Pupil-dilated; 50° field of view.
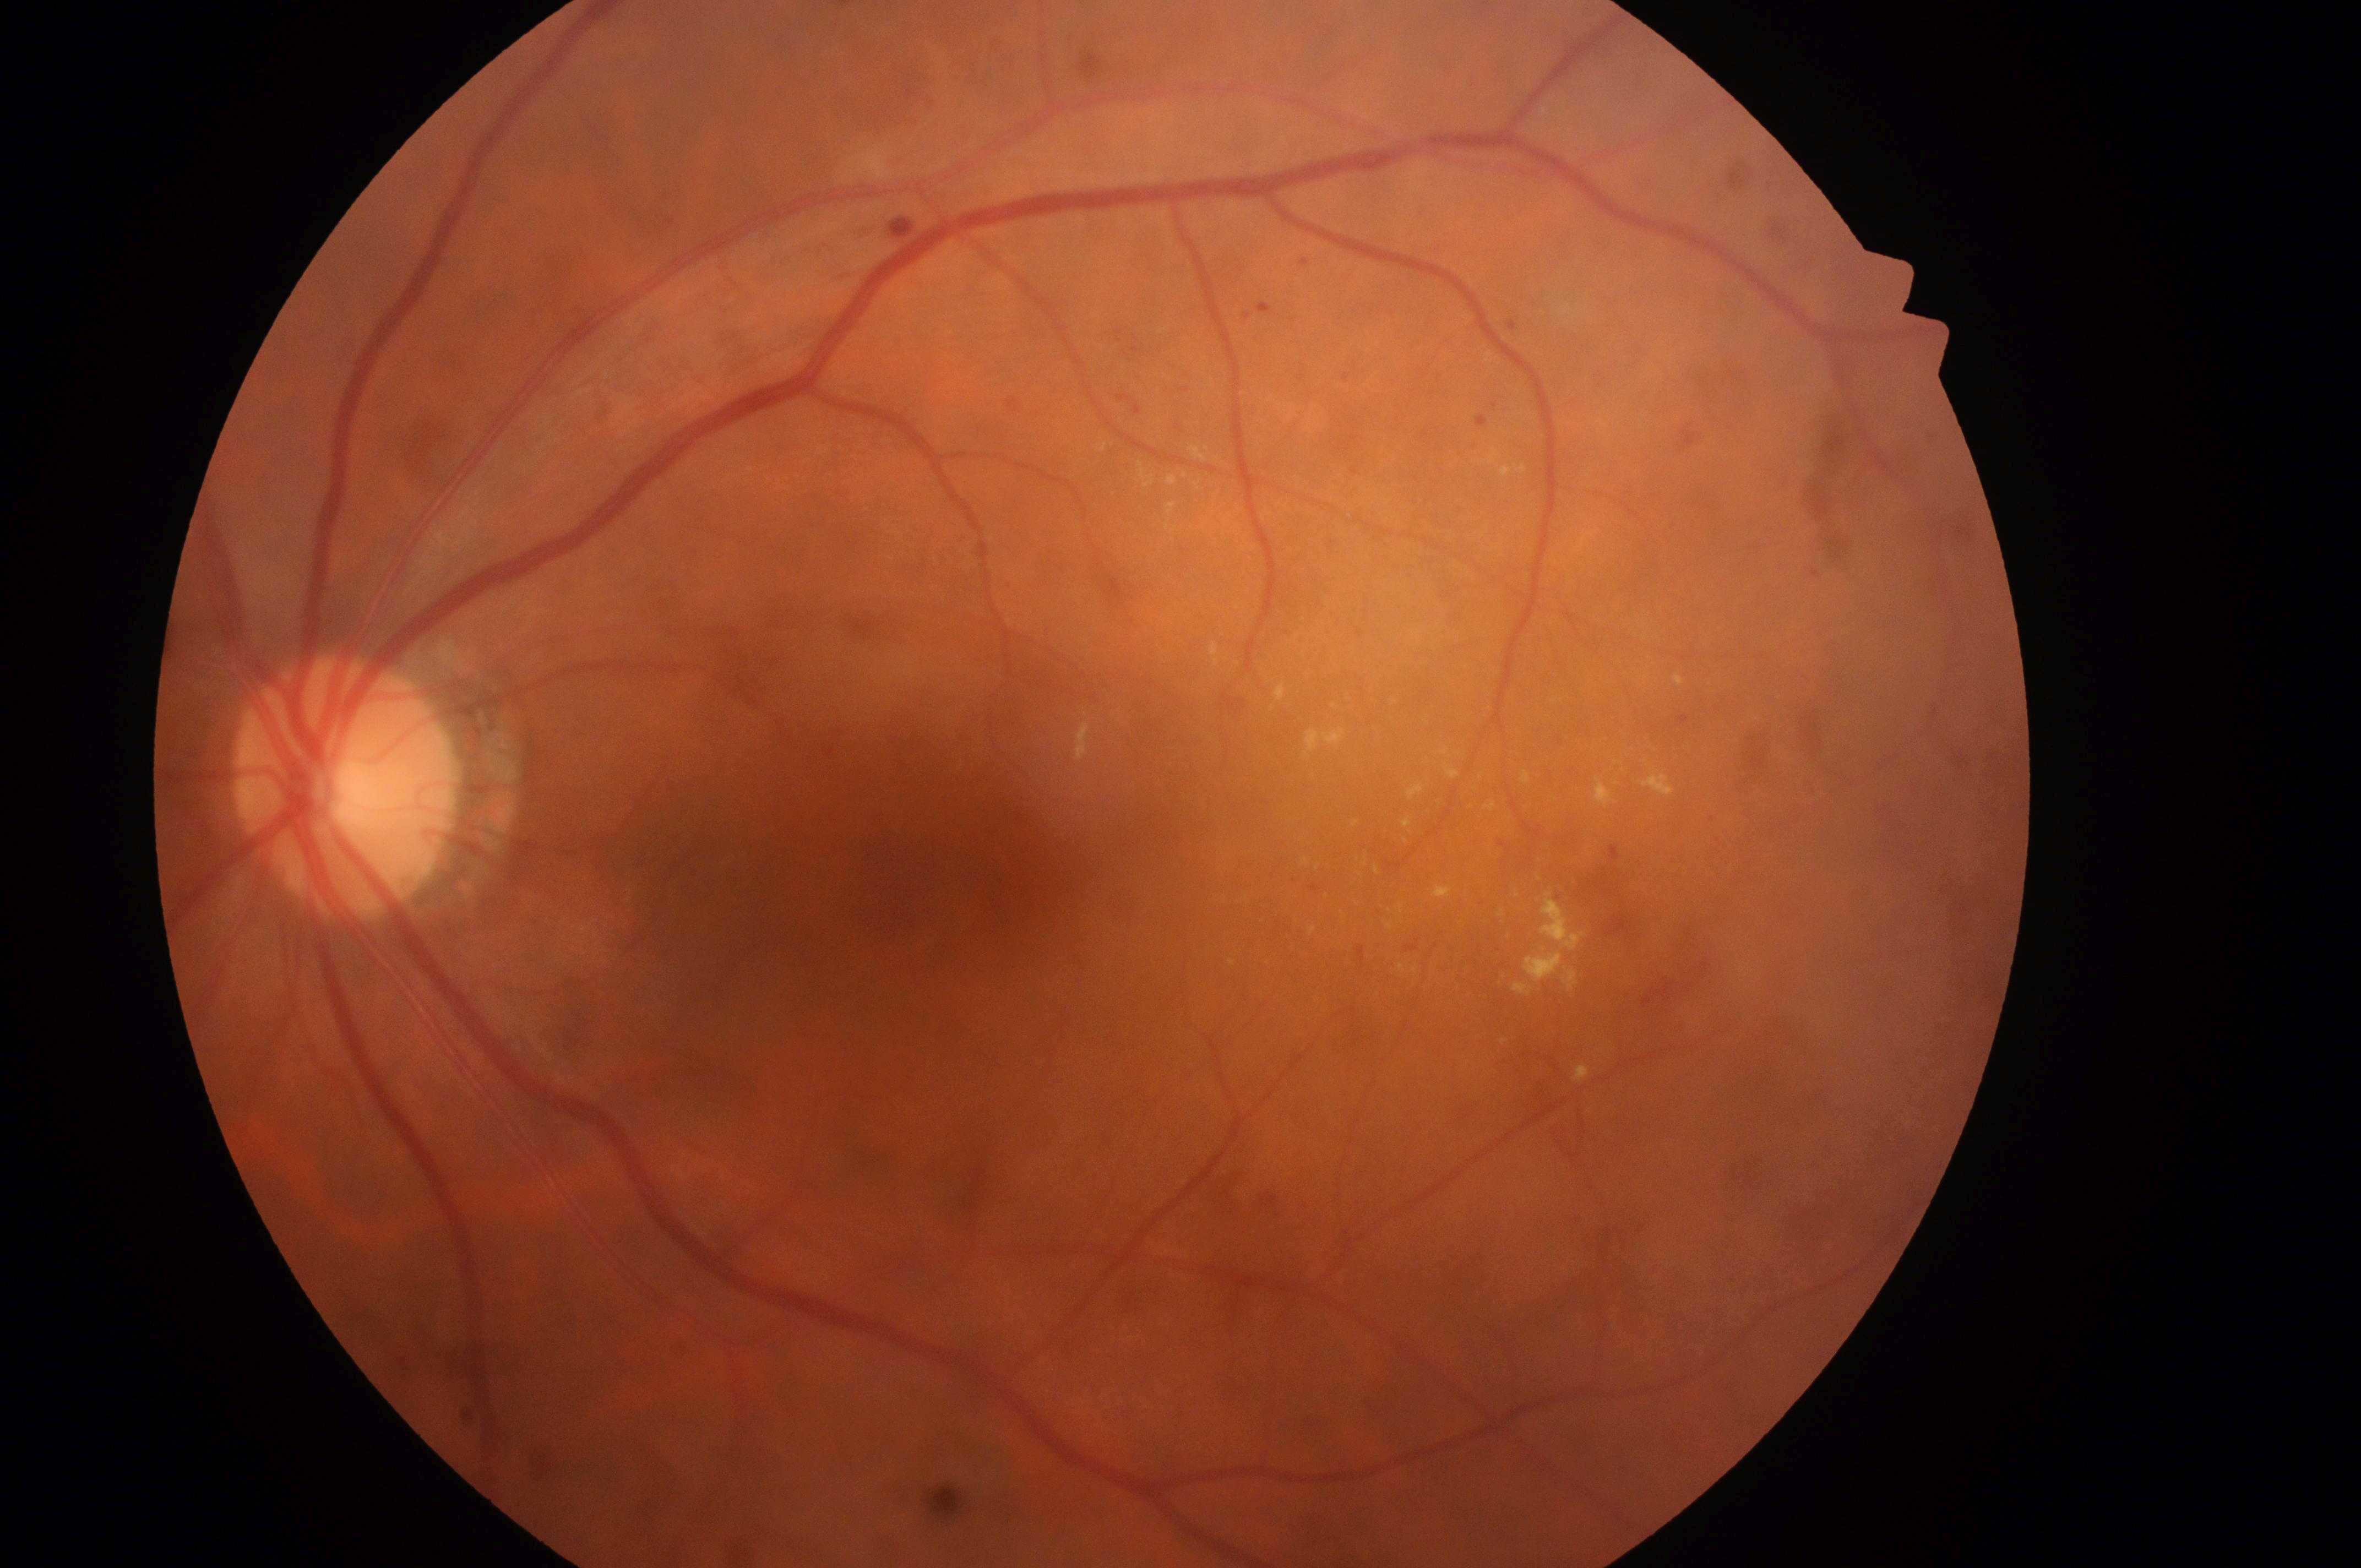

Findings:
– macular edema risk: grade 2
– macula center: (x: 994, y: 864)
– DR class: non-proliferative diabetic retinopathy
– ONH: (x: 342, y: 793)
– diabetic retinopathy: grade 3
– laterality: the left eye